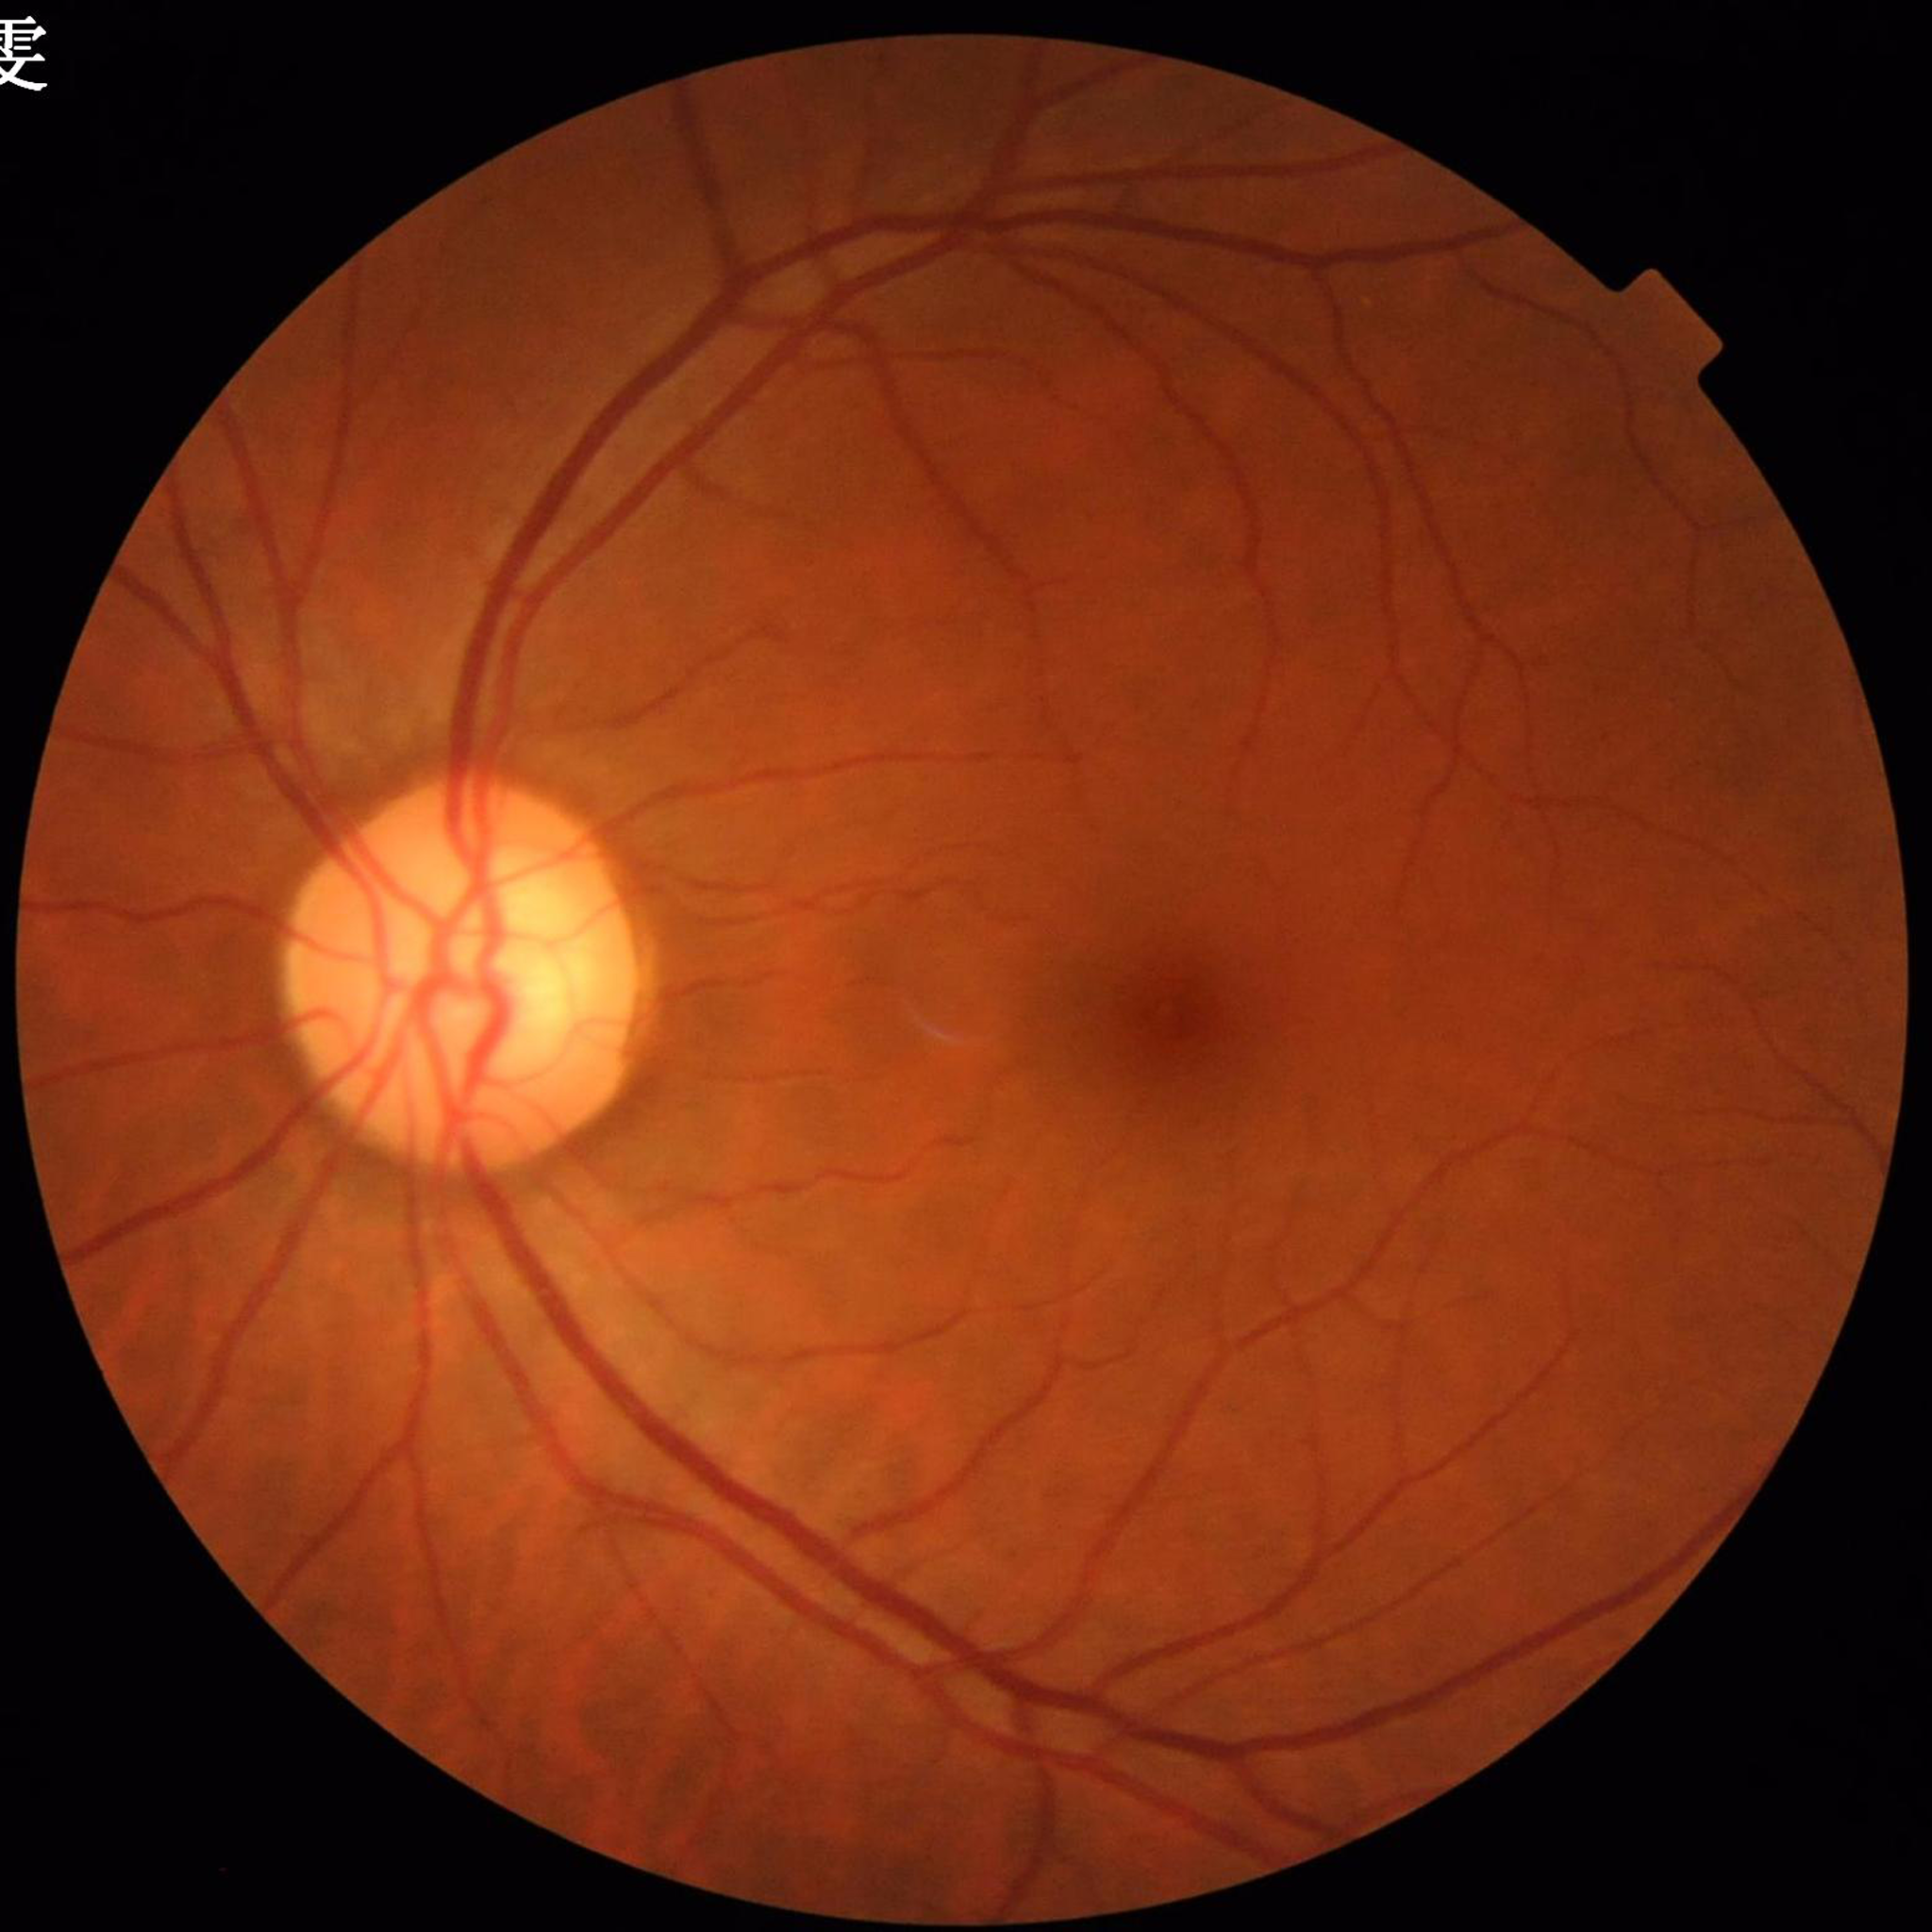
Condition: glaucoma.